Camera: Natus RetCam Envision (130° FOV) · RetCam wide-field infant fundus image — 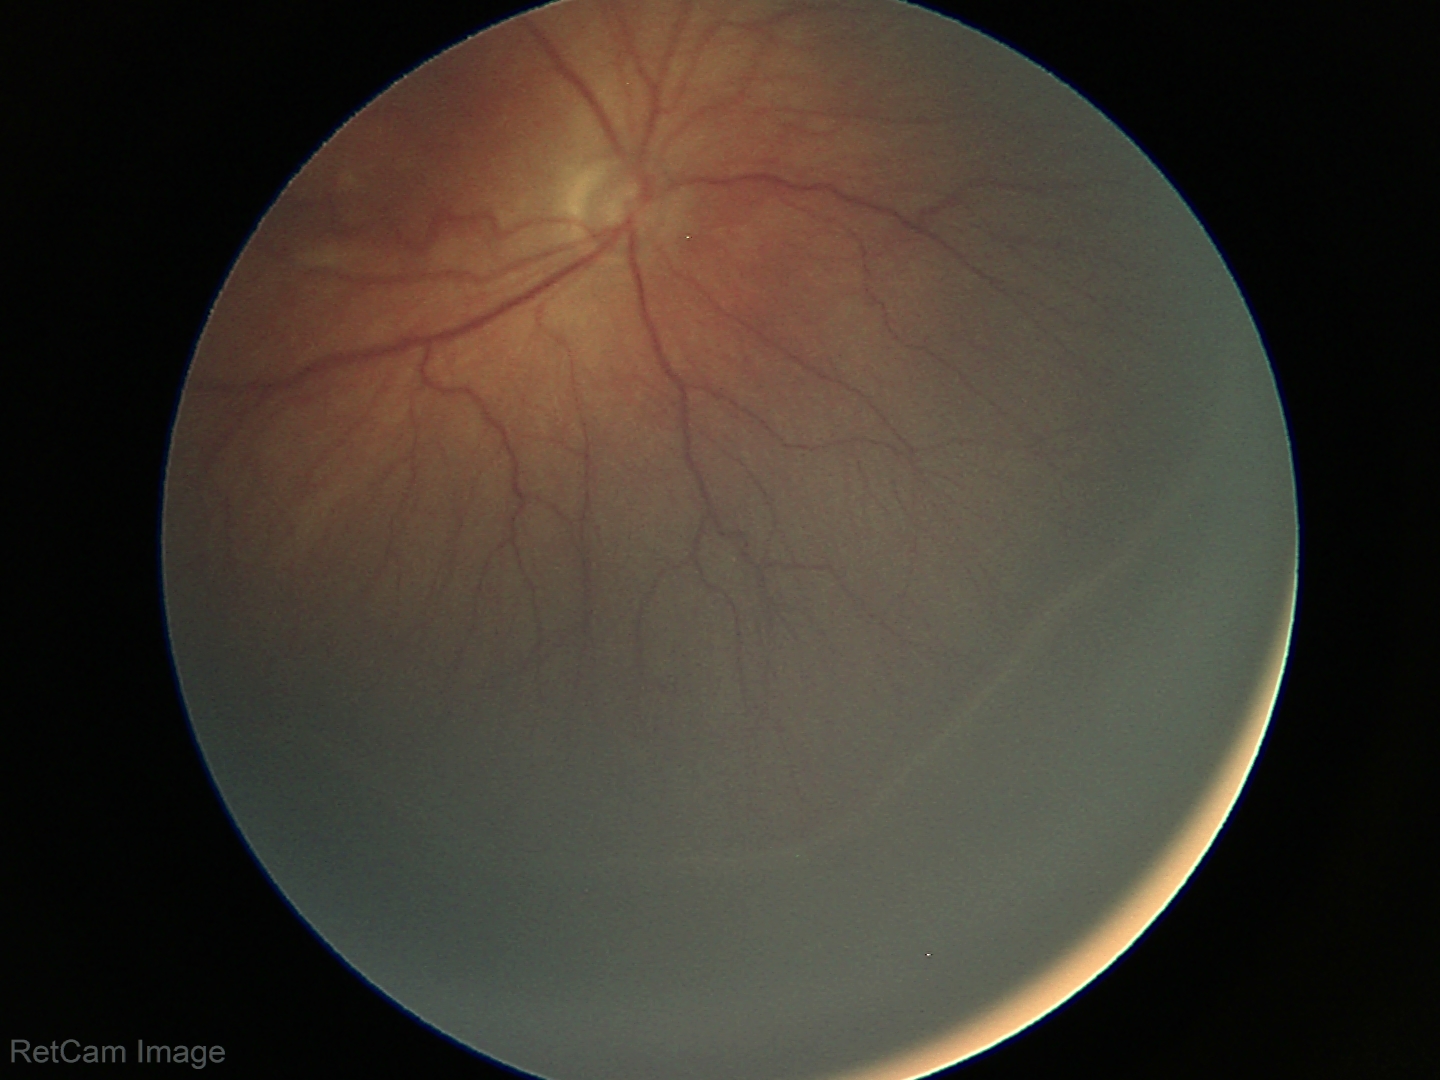 Series diagnosed as retinopathy of prematurity (ROP) stage 3.
Plus disease absent.